2346x1568px. Retinal fundus photograph. 45-degree field of view: 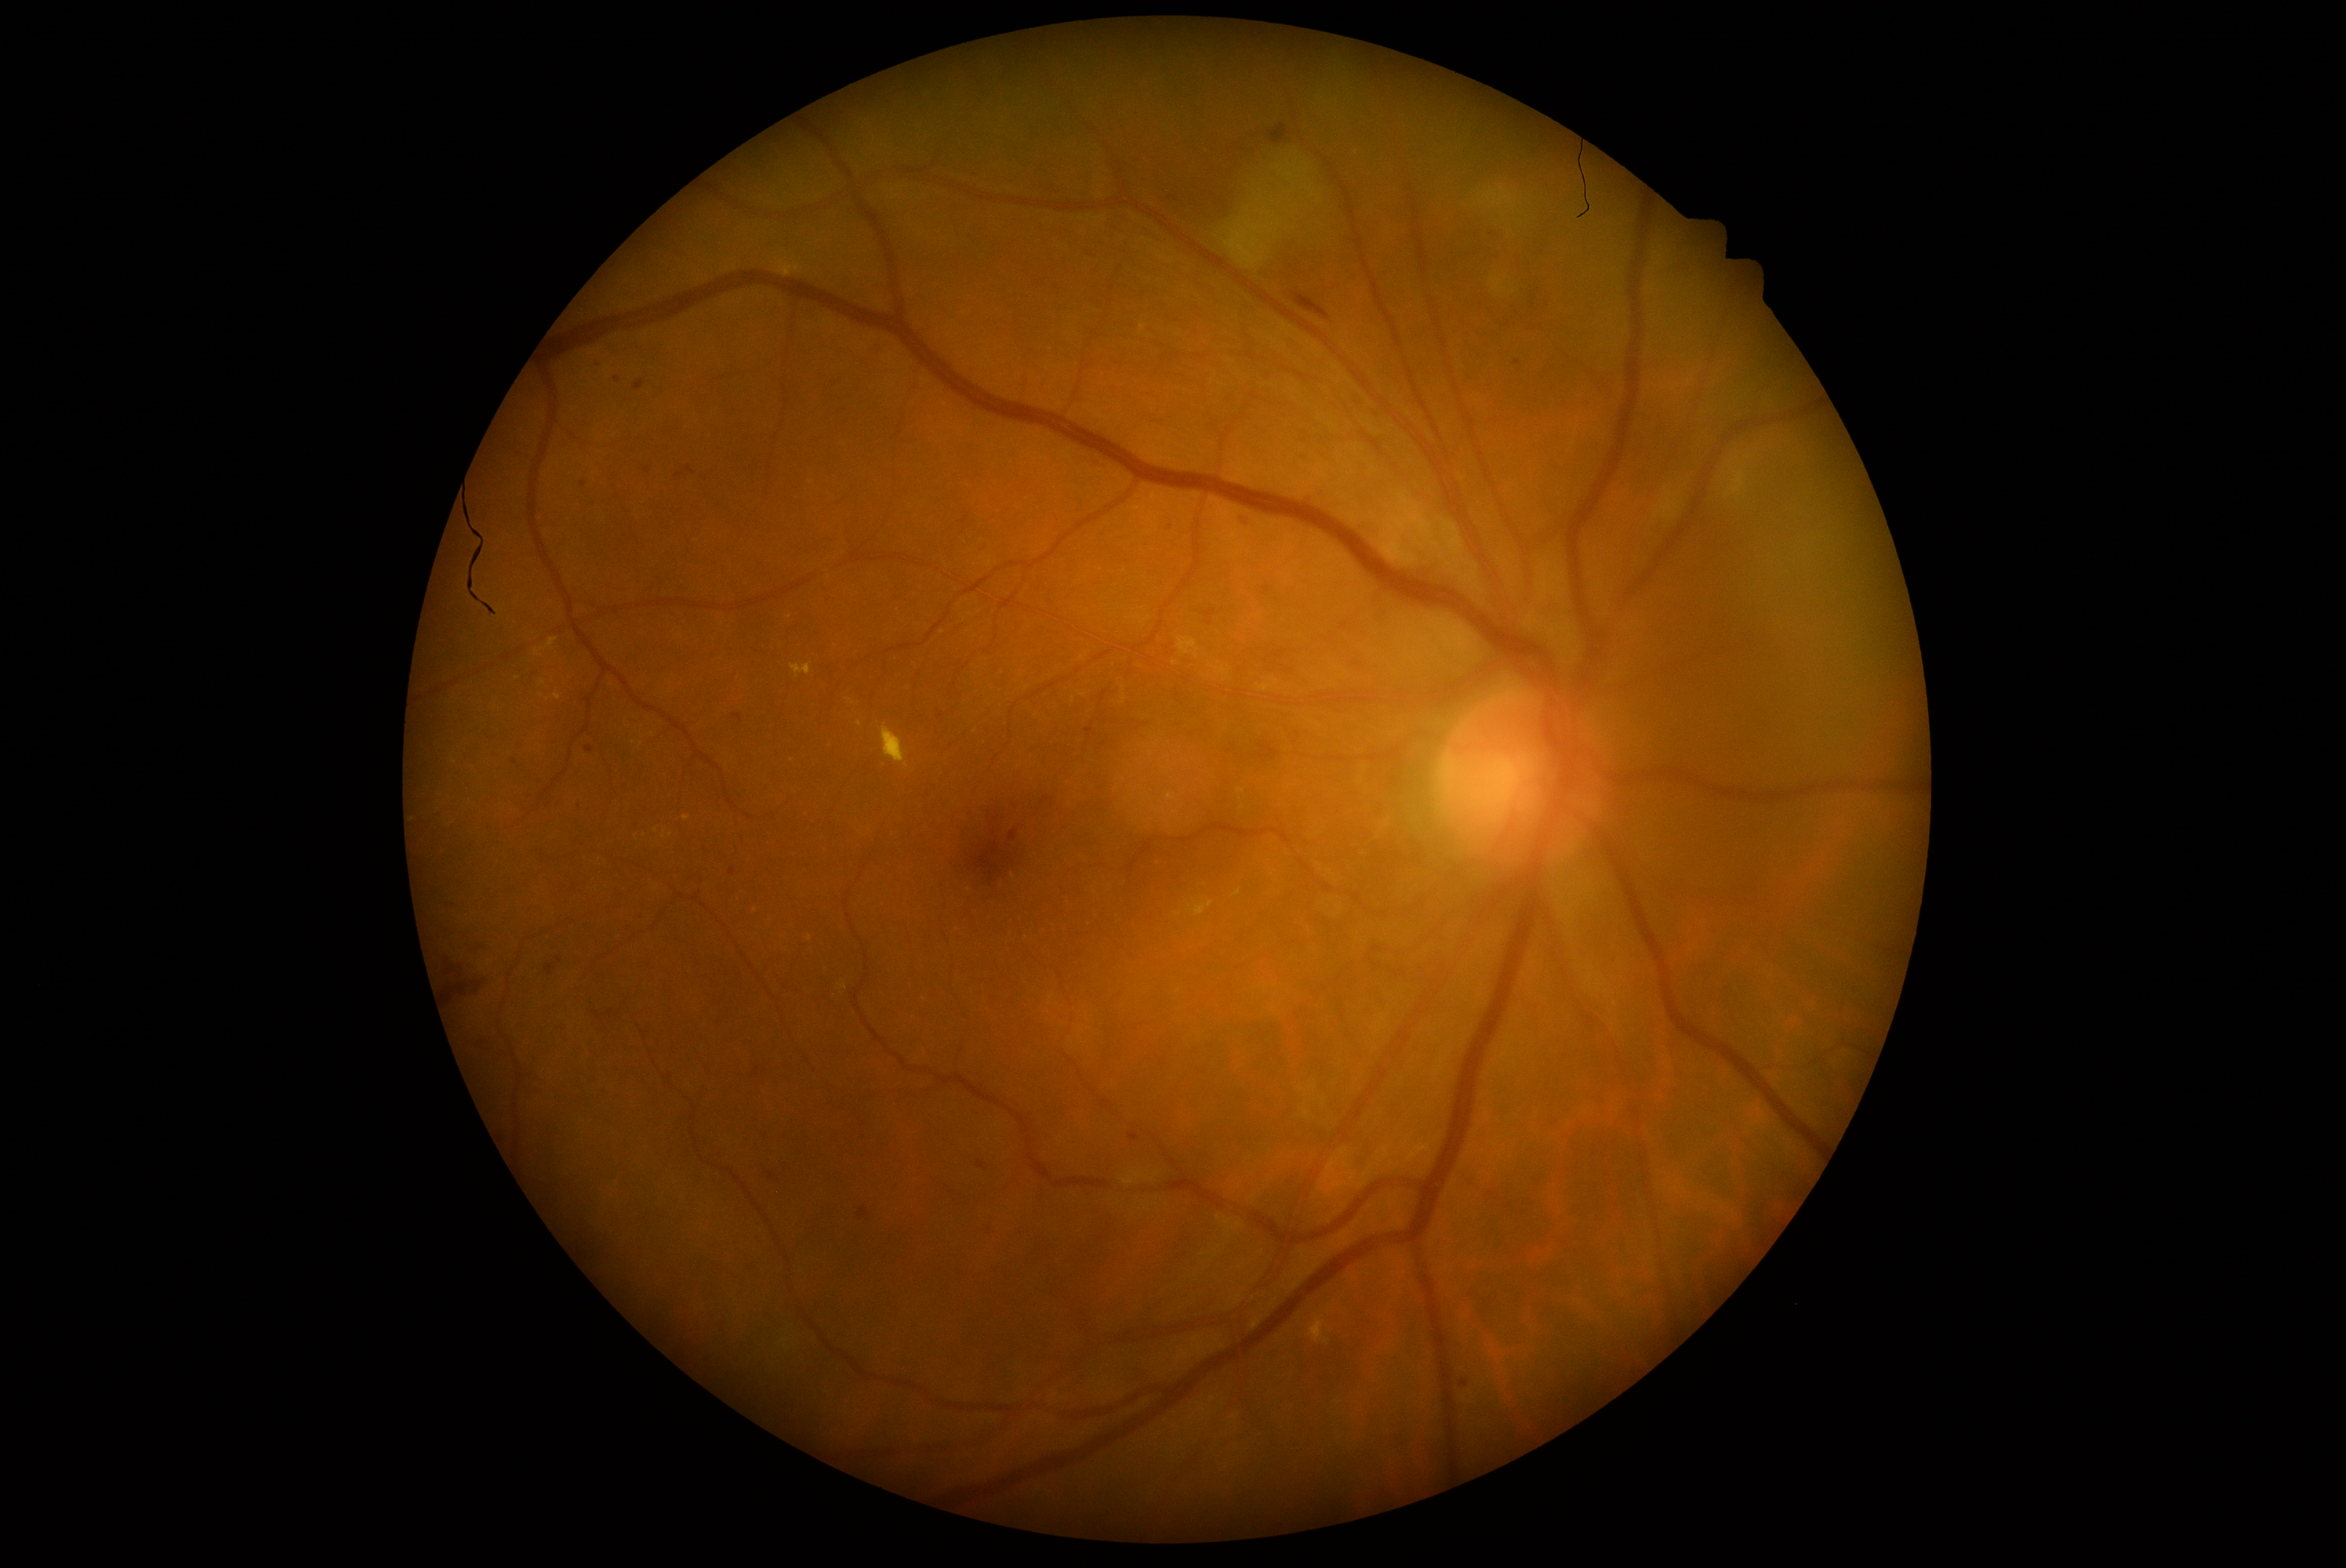 {"partial":true,"dr_grade":2,"dr_grade_name":"moderate NPDR","lesions":{"ma":[[1464,1178,1475,1186],[733,714,743,724],[1008,829,1019,843],[962,515,970,524],[634,382,644,391],[1514,360,1522,366],[978,1163,986,1171],[586,747,594,753]],"ma_small":[[866,1140],[577,808],[600,363],[618,381],[1170,527],[767,1136]]}}